Image size 2212x1659 · CFP · 45° field of view.
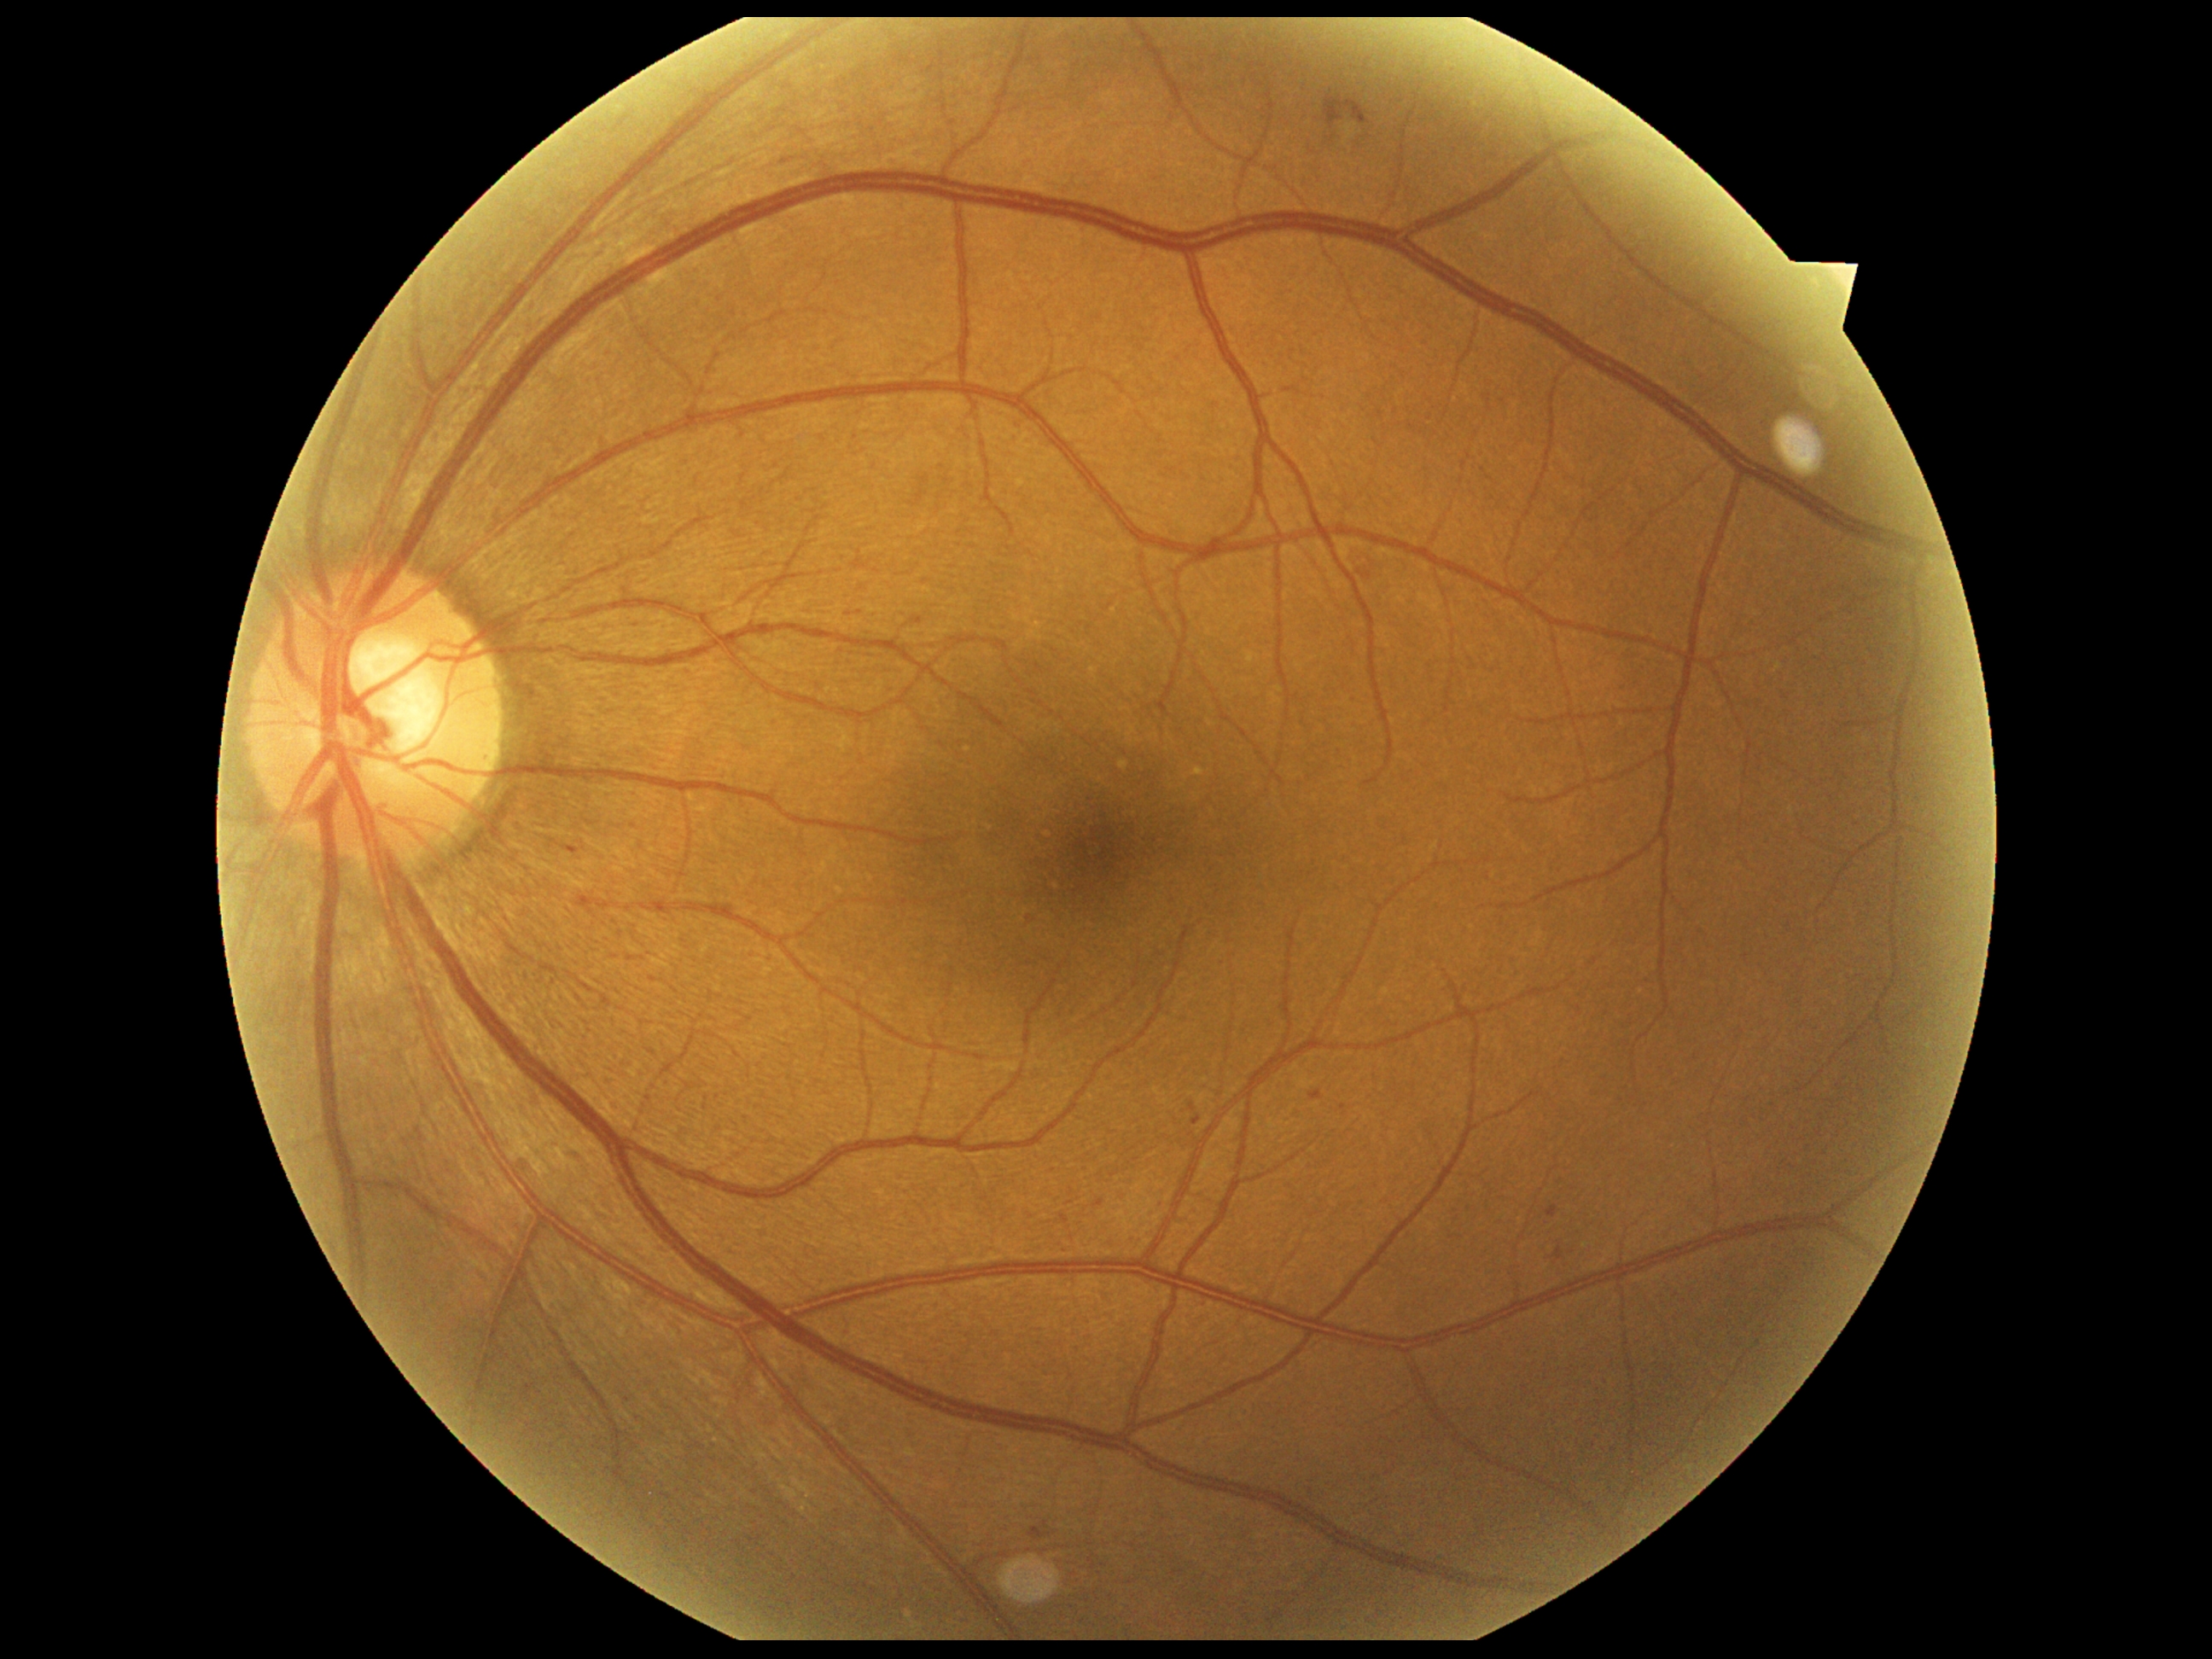 {"dr_grade":2,"lesions":{"ex":null,"se":null,"ma":[[1310,1091,1324,1102],[1095,1201,1103,1208],[911,619,923,626],[568,849,579,856],[1189,1102,1197,1112],[1556,1245,1564,1262],[1061,1216,1069,1223],[1194,1117,1202,1126],[1547,1206,1561,1218]],"ma_small_centers":[[1030,918],[926,582],[634,825],[1115,1176]],"he":[[1325,96,1371,127],[1359,571,1373,581],[1030,1528,1054,1540]]}}